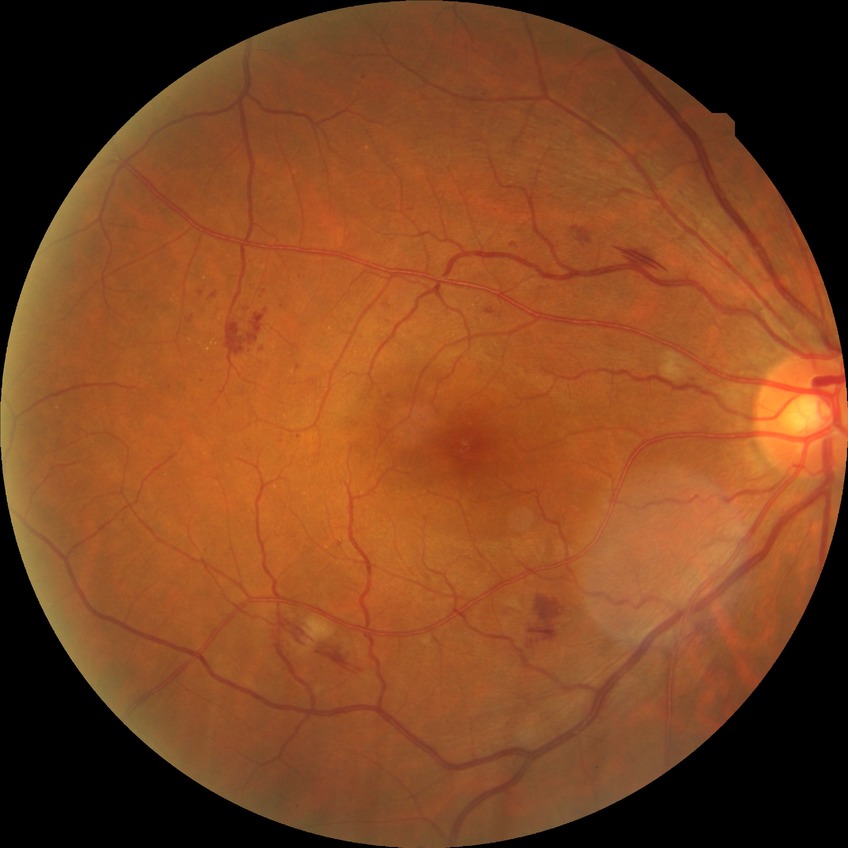

modified Davis grade = PPDR.